848 by 848 pixels · acquired with a NIDEK AFC-230: 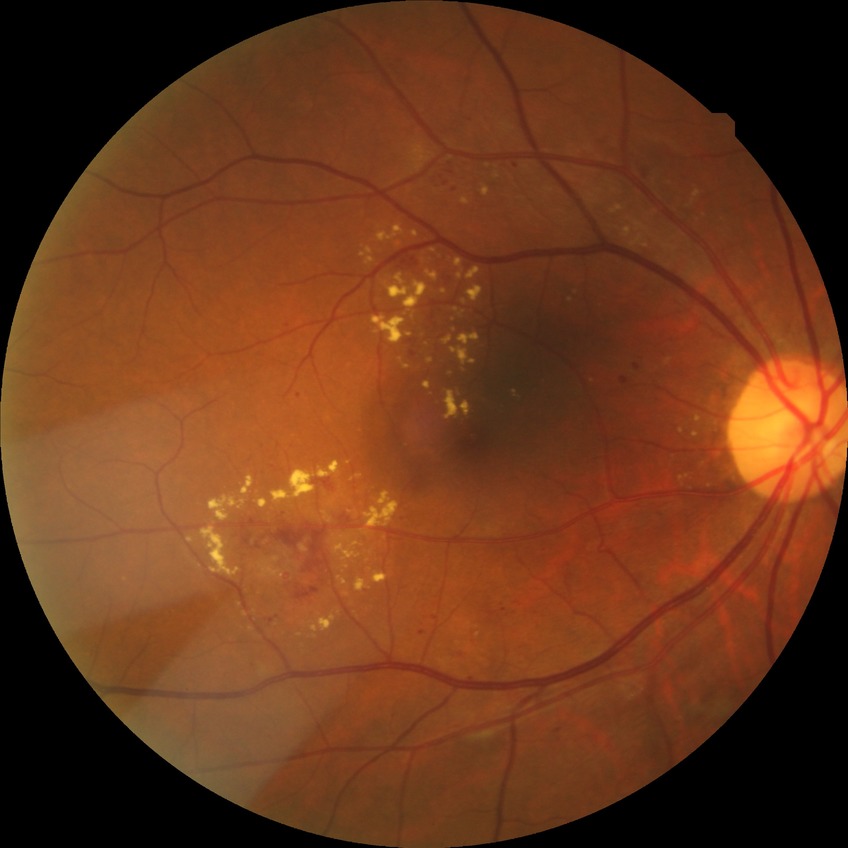

Findings:
* diabetic retinopathy (DR) — SDR (simple diabetic retinopathy)